50° field of view; color fundus photograph; 1932 x 1932 pixels
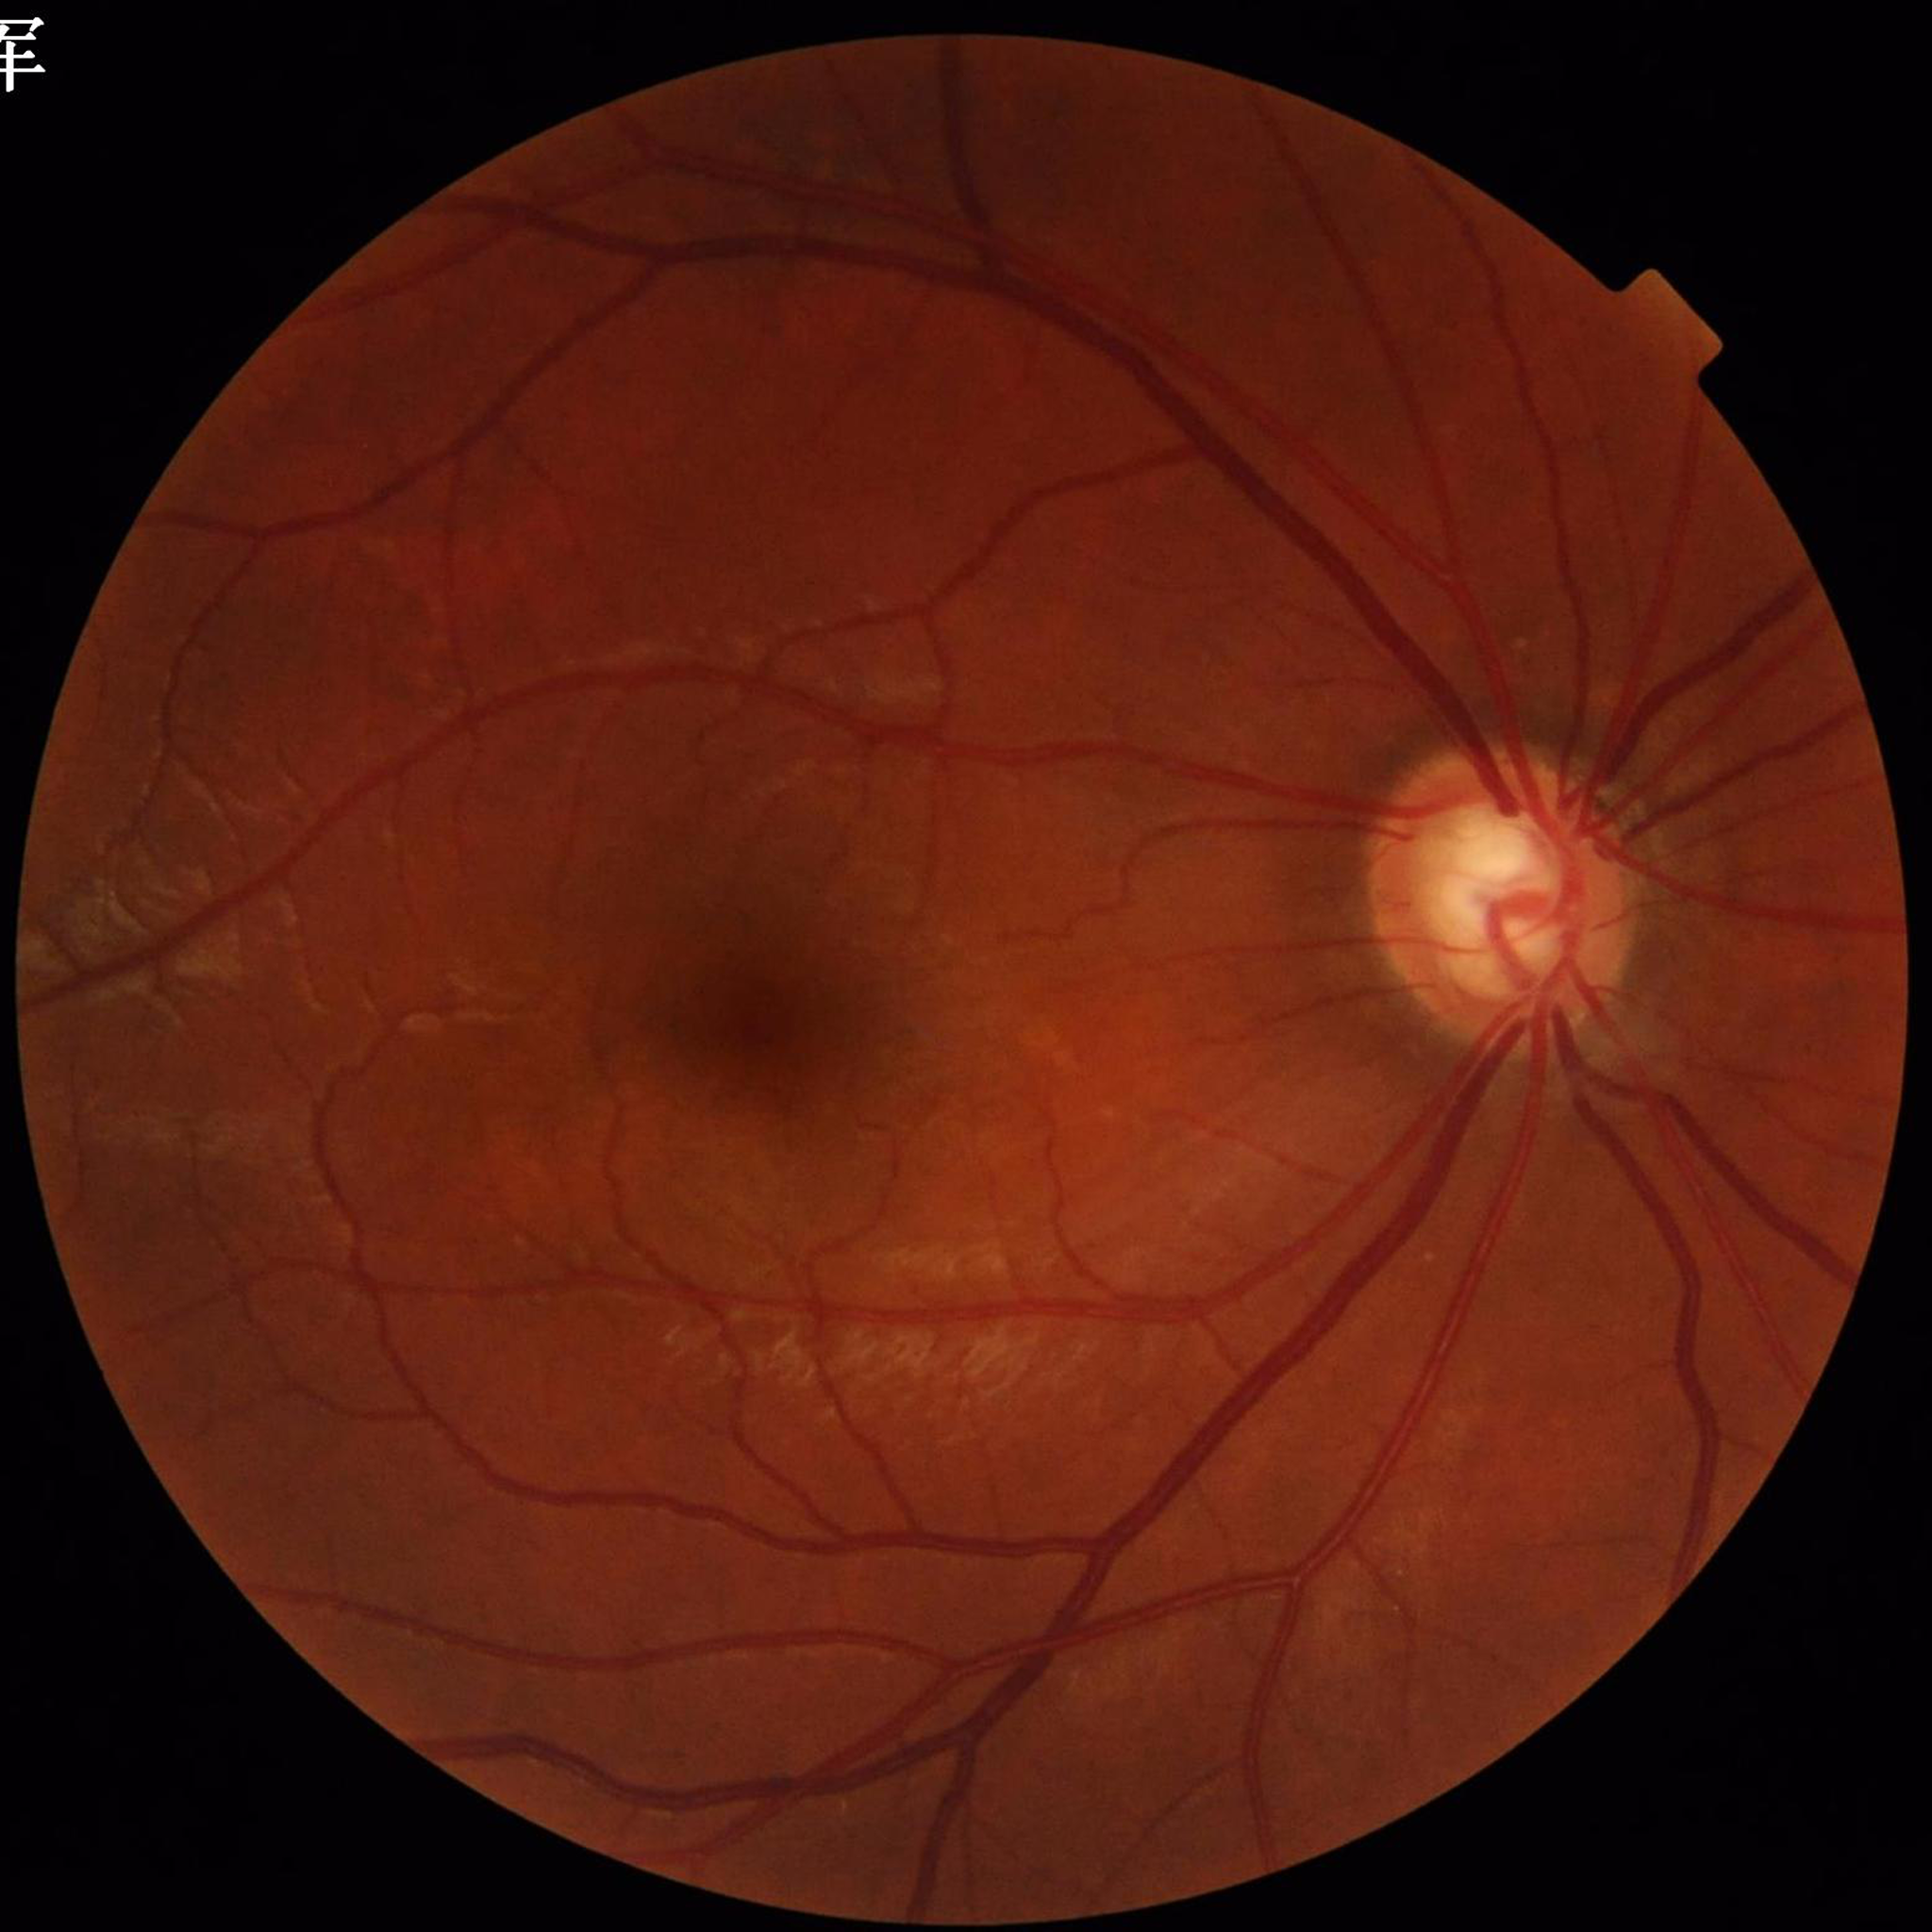 Diagnosis: glaucoma.